Wide-field fundus photograph from neonatal ROP screening · captured with the Phoenix ICON (100° field of view) · 1240 x 1240 pixels — 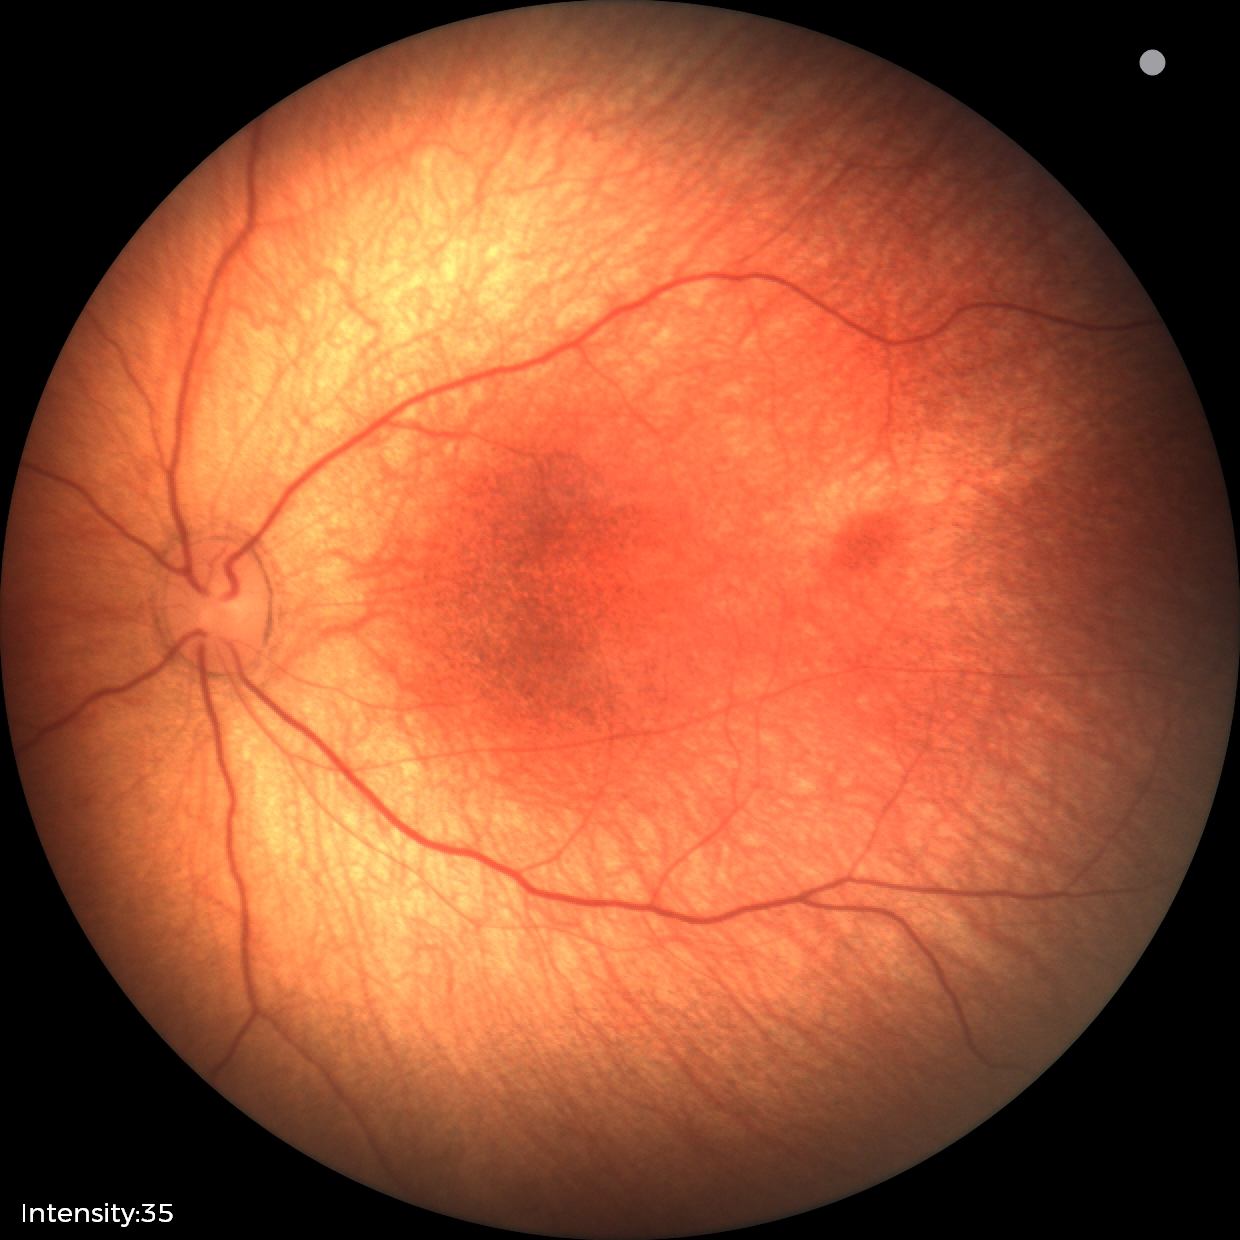

Normal screening examination.